Infant wide-field fundus photograph; 1240 by 1240 pixels; Phoenix ICON, 100° FOV.
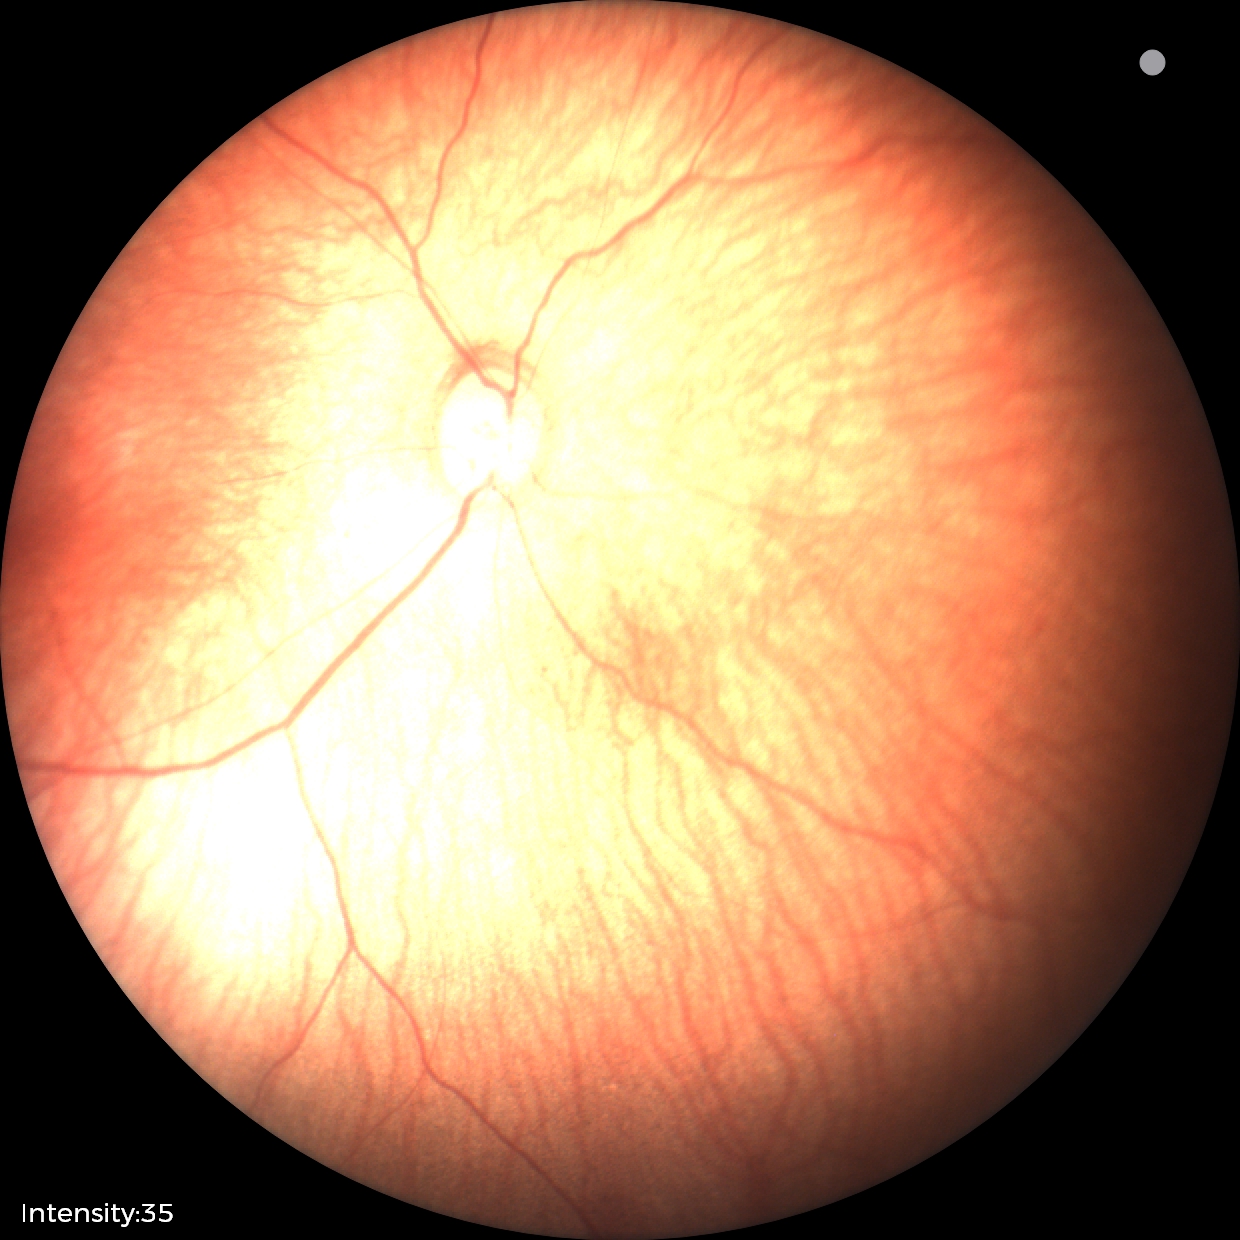

Impression: normal retinal appearance.